Modified Davis classification — 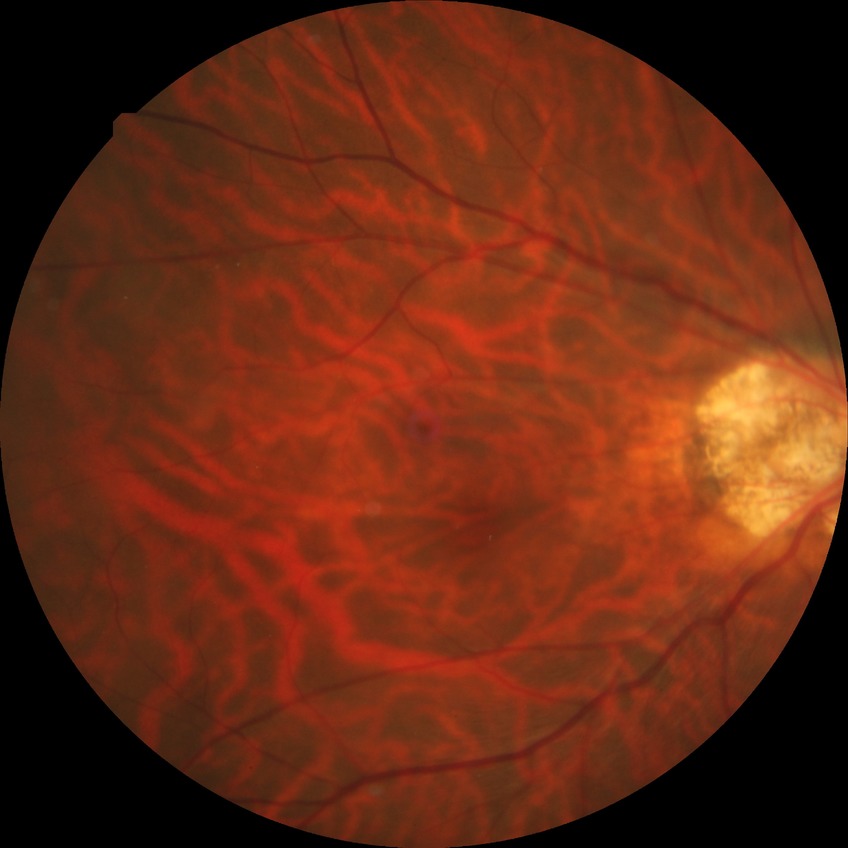

Assessment:
- diabetic retinopathy (DR): NDR (no diabetic retinopathy)